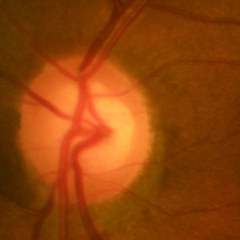 Optic nerve head appearance consistent with no glaucoma.